Davis DR grading — 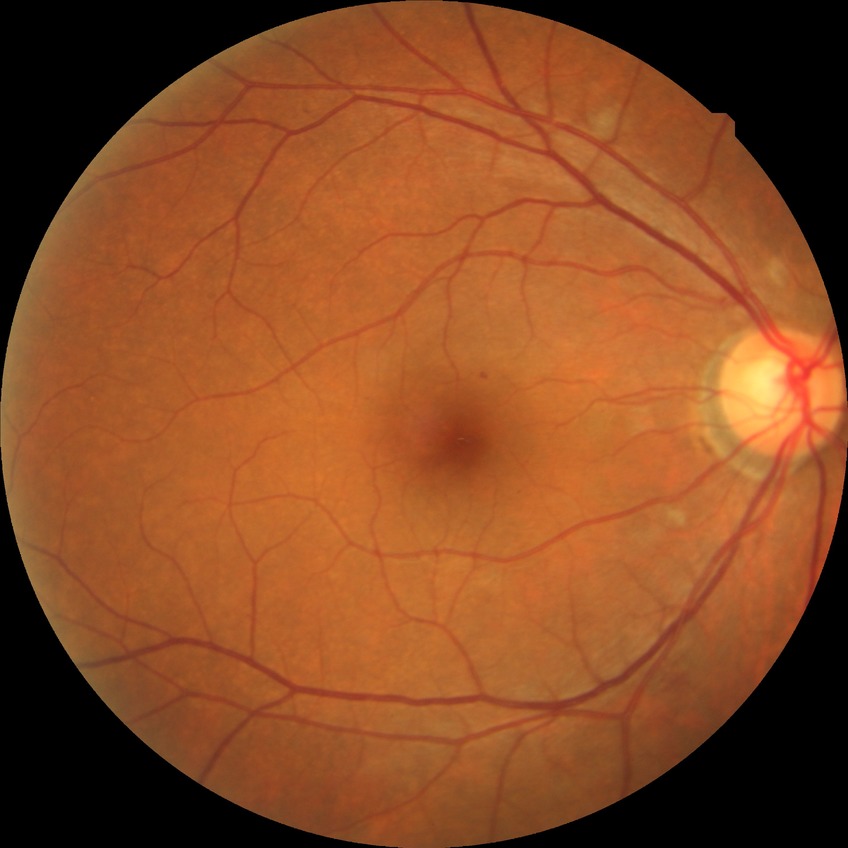
  davis_grade: no diabetic retinopathy